Wide-field contact fundus photograph of an infant:
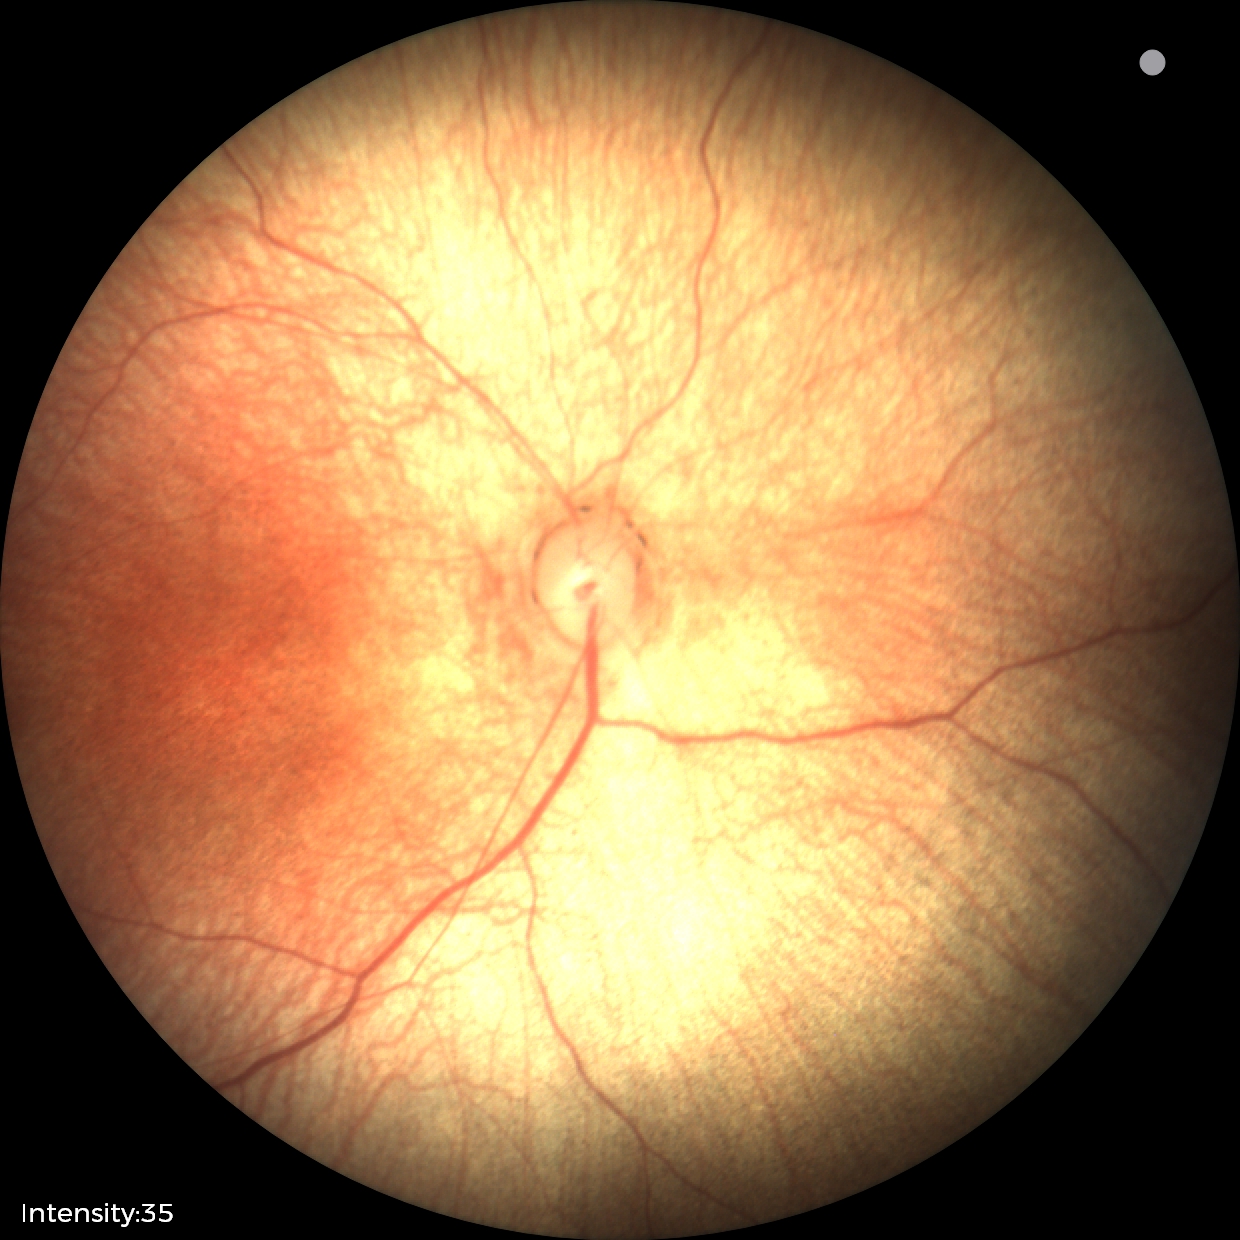
Screening diagnosis: normal fundus examination.